Image size 640x480; infant wide-field fundus photograph — 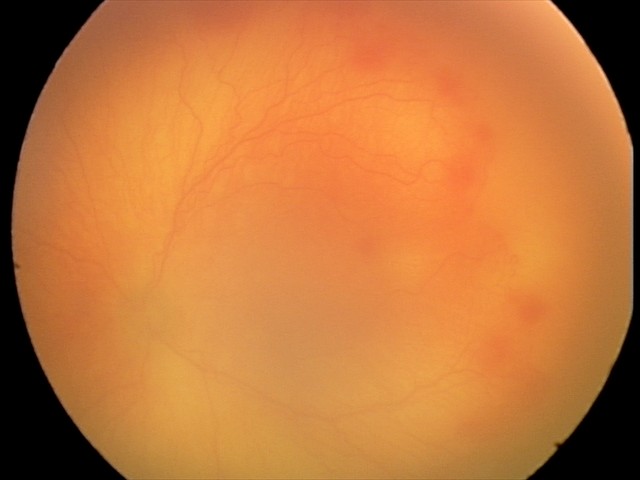

Screening series with aggressive ROP (A-ROP). Plus disease was diagnosed.